Modified Davis classification:
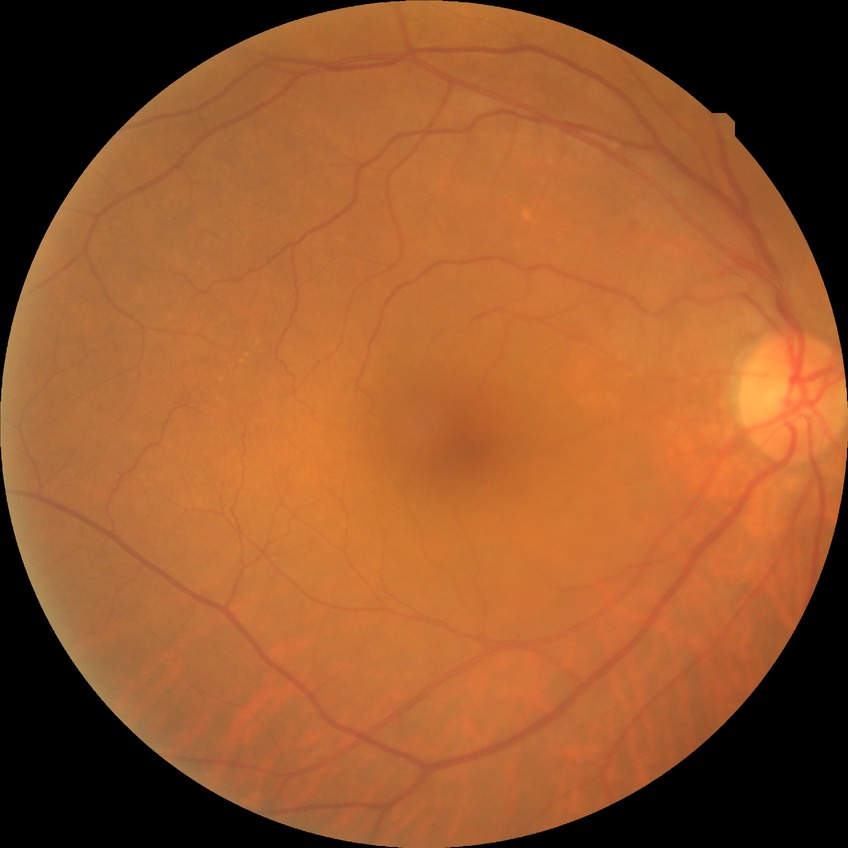
modified Davis grading@no diabetic retinopathy.